45° field of view
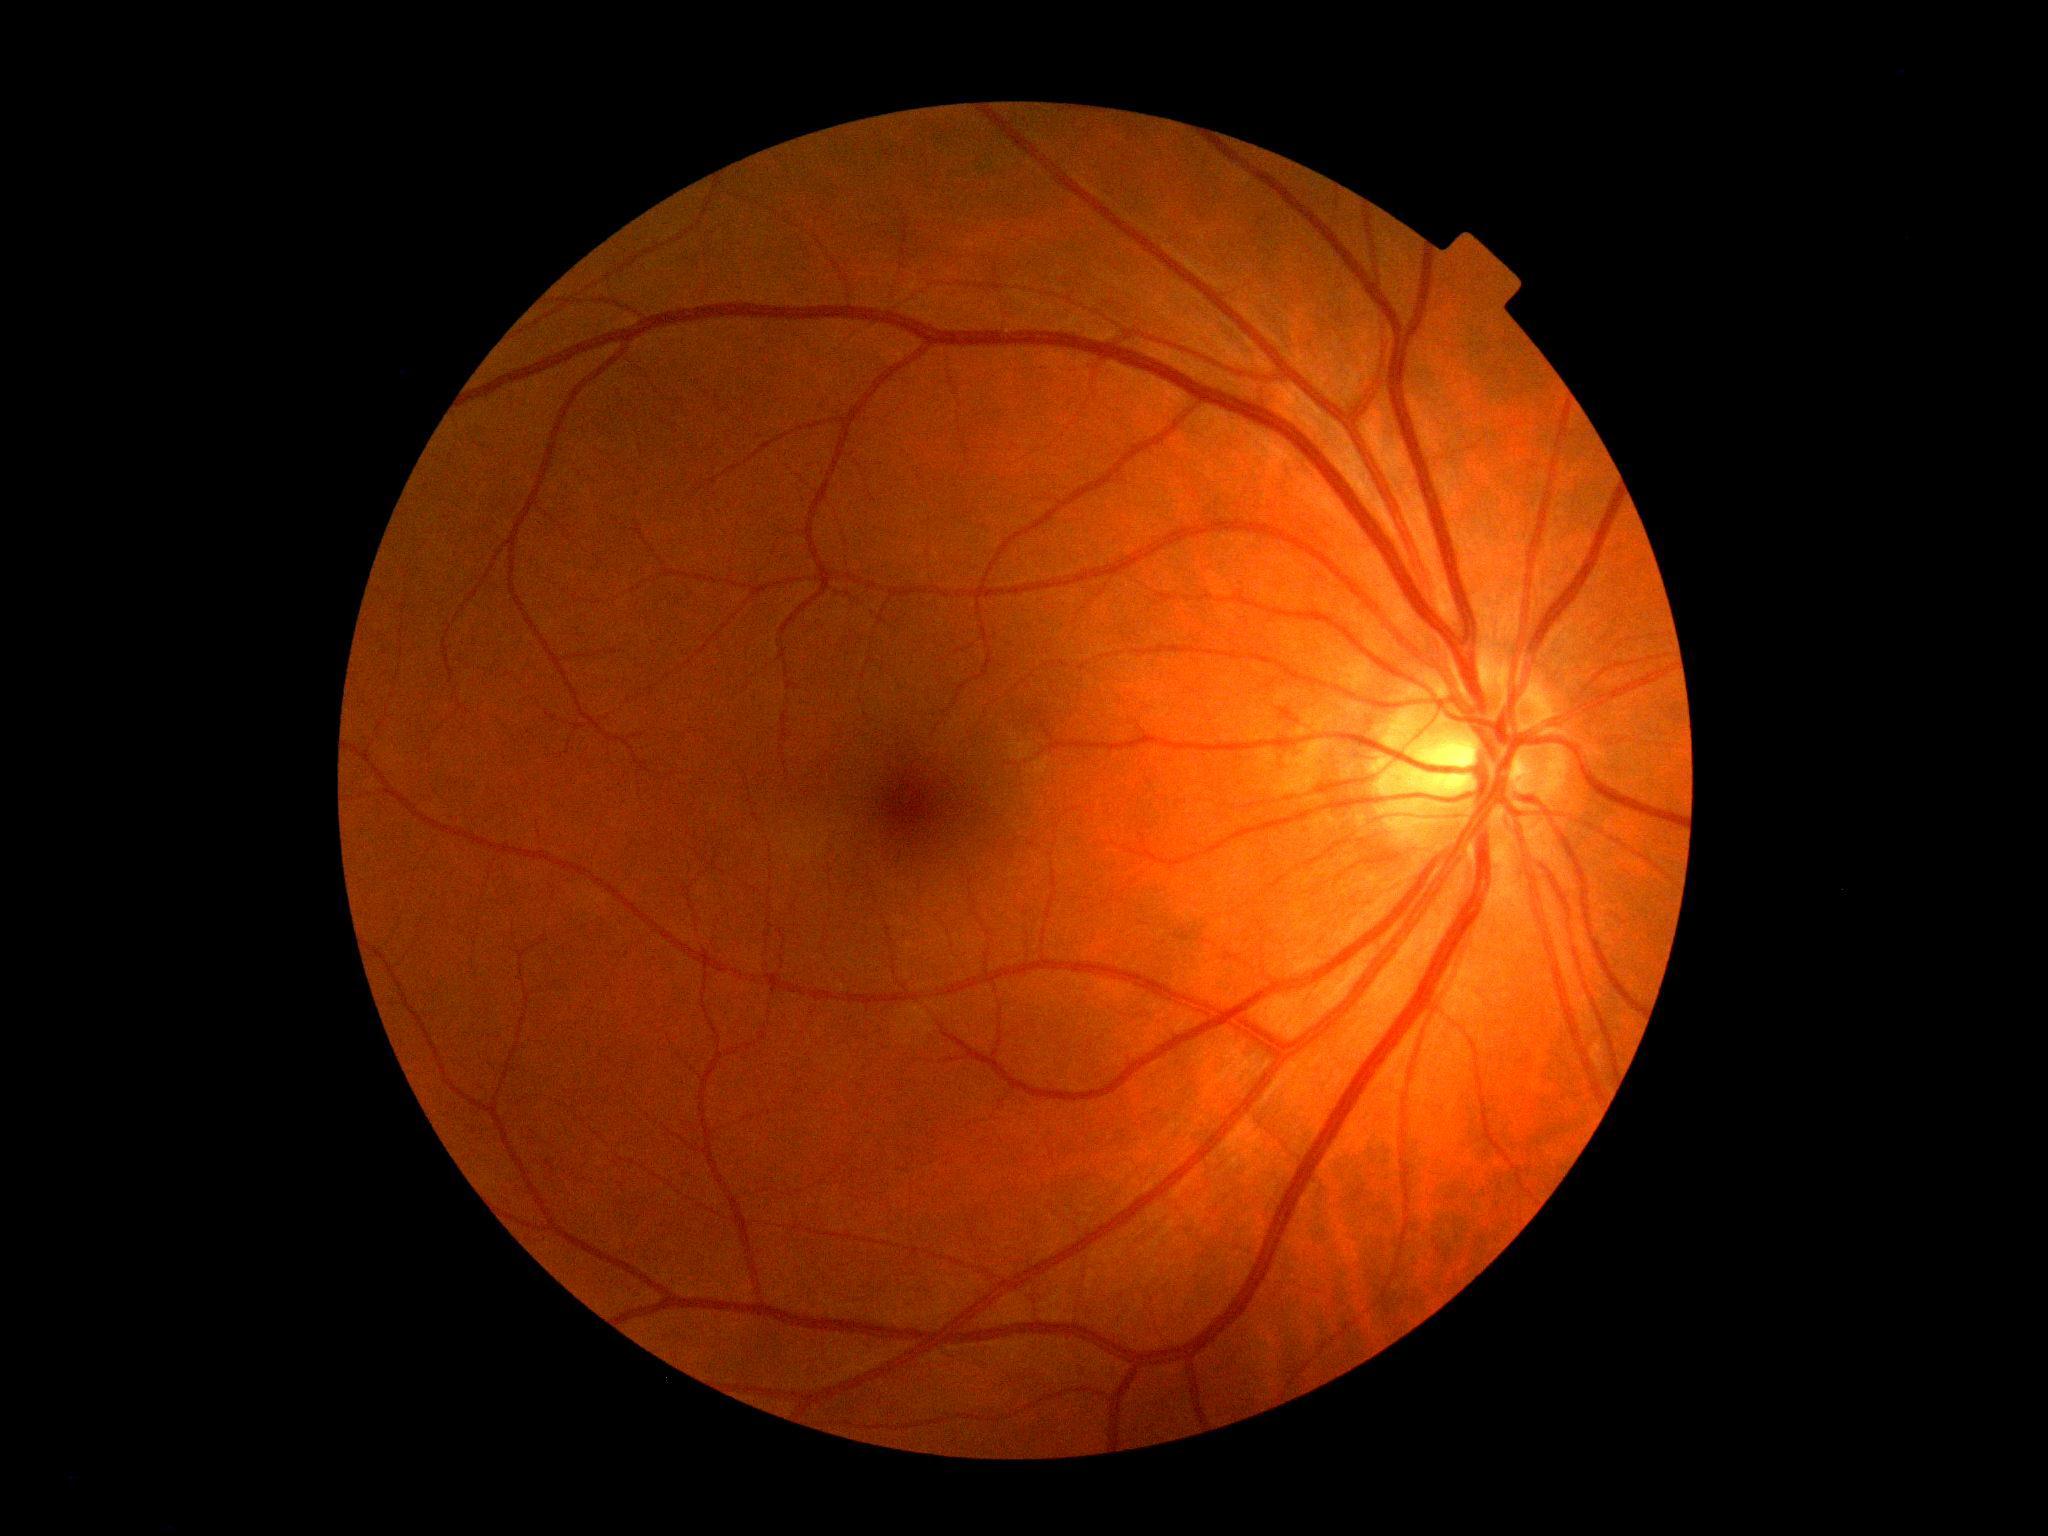 Retinopathy grade is 0 (no apparent retinopathy) — no visible signs of diabetic retinopathy.